Wide-field fundus photograph of an infant: 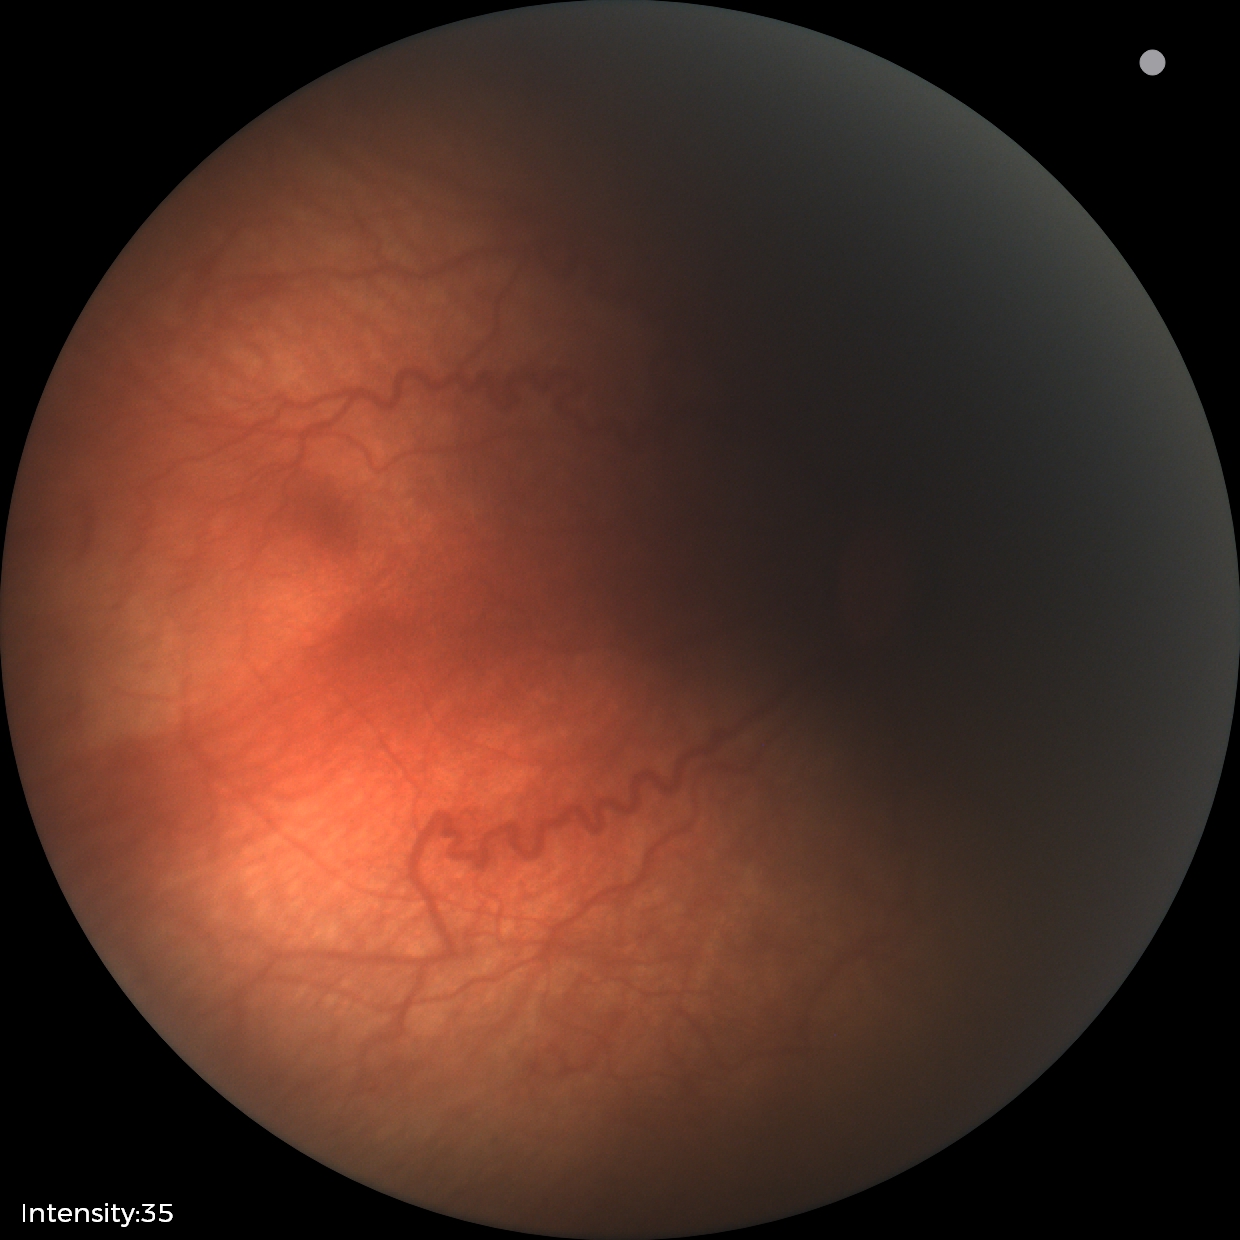
Impression: retinopathy of prematurity stage 2
plus disease: present